1240 x 1240 pixels. 100° field of view (Phoenix ICON). Wide-field contact fundus photograph of an infant:
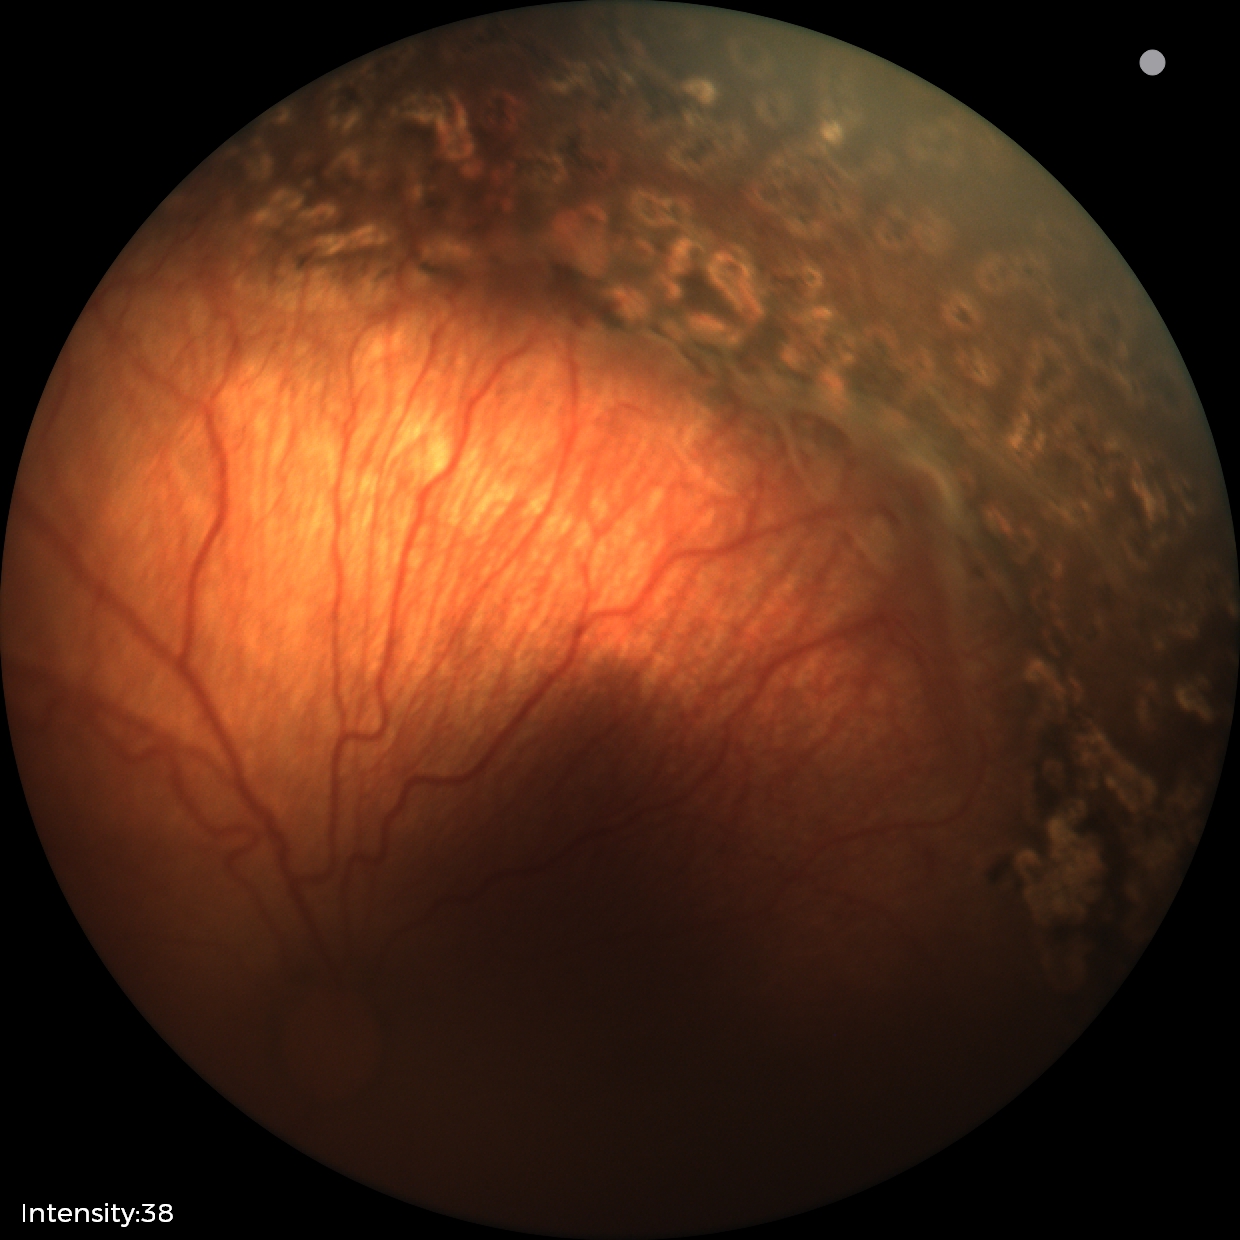

Plus disease absent.
Screening series with status post retinopathy of prematurity (ROP).